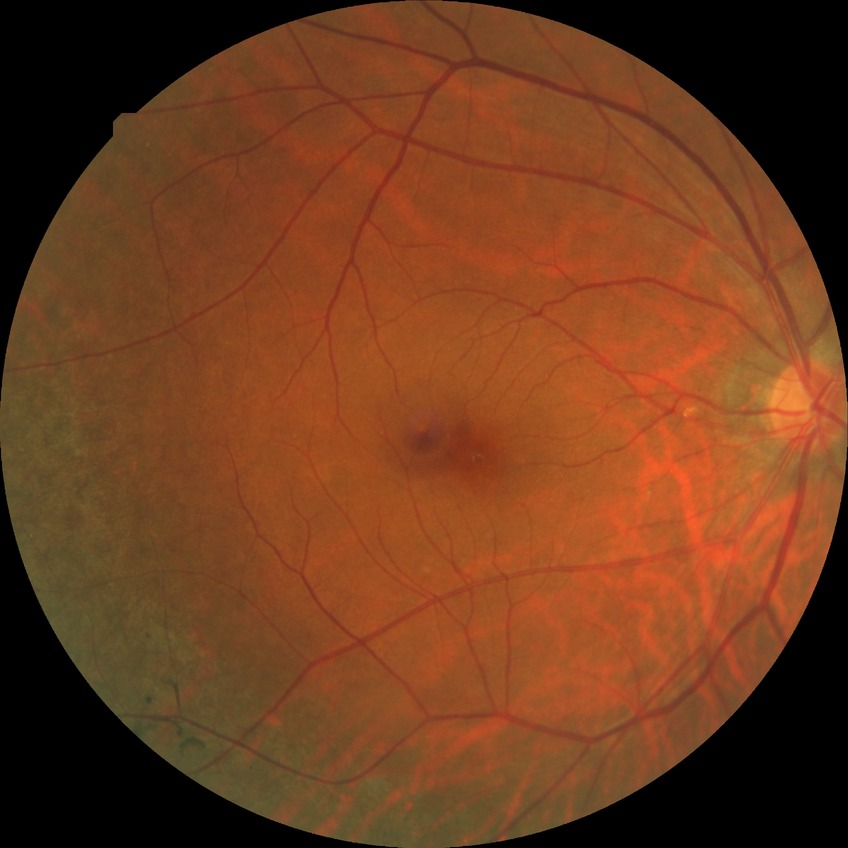

diabetic retinopathy (DR)@no diabetic retinopathy (NDR).